Color fundus photograph — 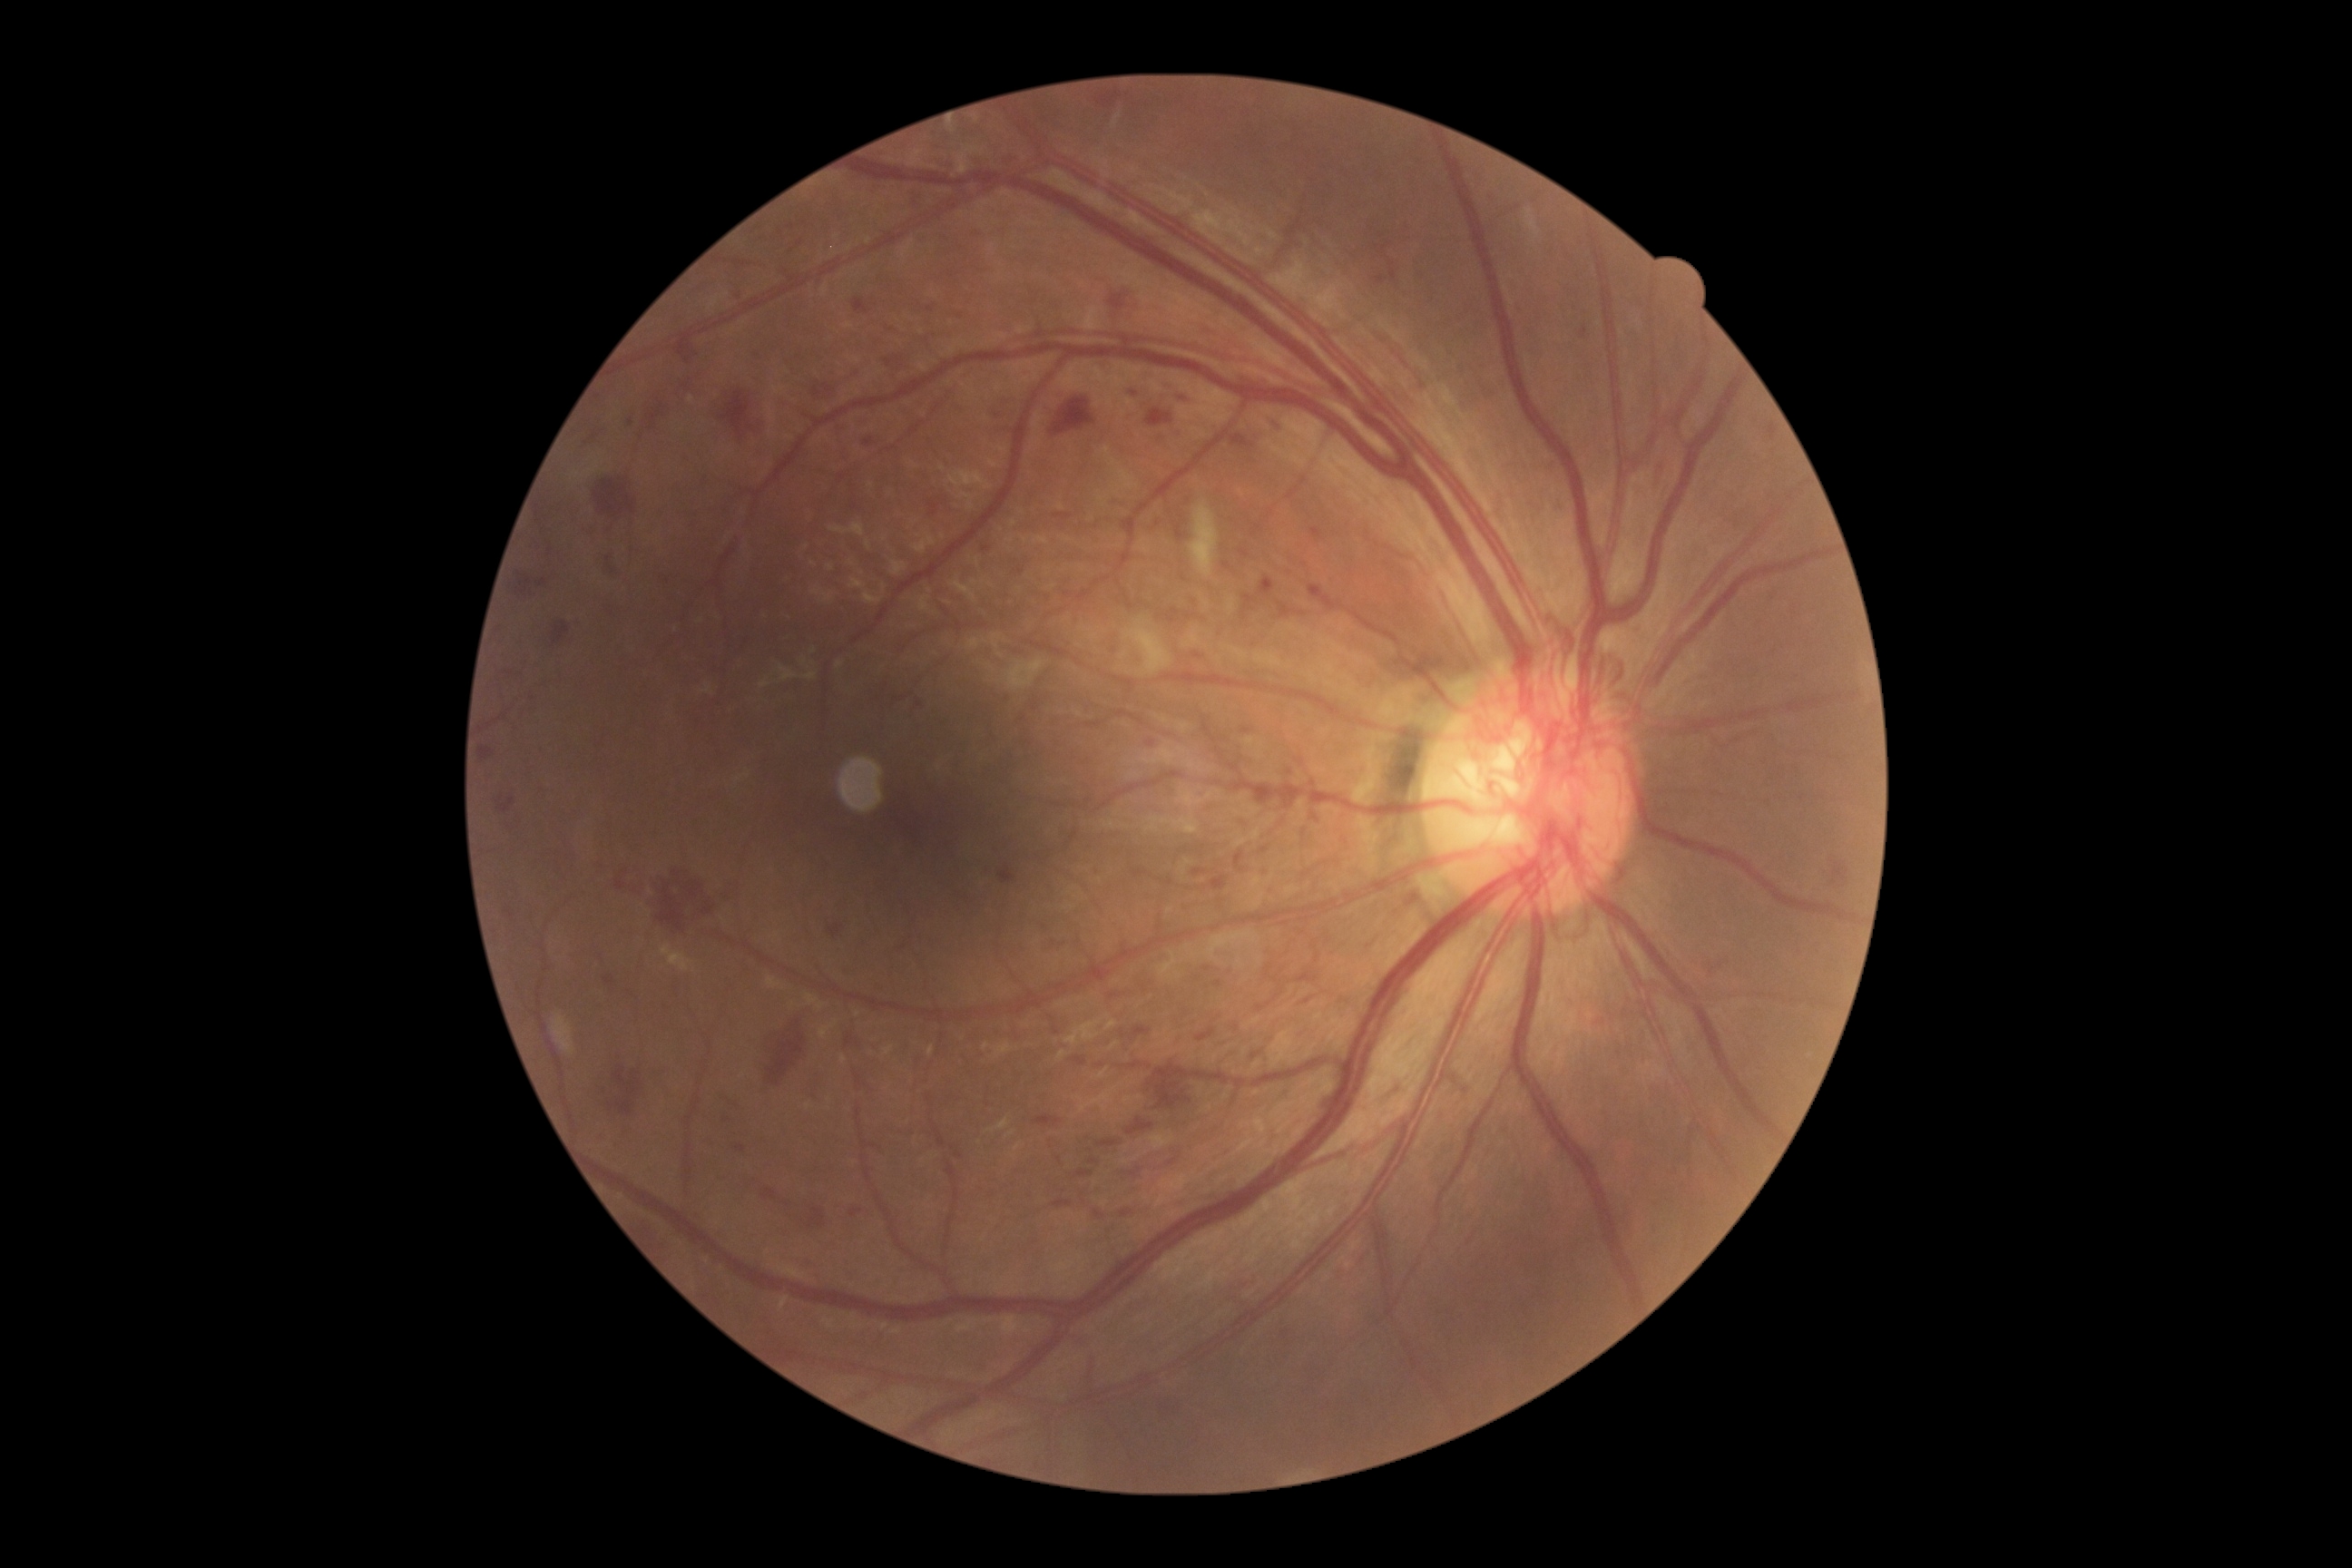

Diabetic retinopathy (DR) is grade 4 (PDR). Hemorrhages (HEs) include rect(1121, 1208, 1133, 1219) | rect(1260, 578, 1275, 598) | rect(1175, 525, 1184, 540) | rect(498, 663, 525, 676) | rect(990, 400, 1014, 416) | rect(602, 1057, 638, 1117) | rect(607, 556, 618, 574) | rect(1288, 783, 1306, 808) | rect(647, 404, 667, 431) | rect(999, 867, 1015, 885) | rect(1052, 400, 1095, 436) | rect(761, 1190, 778, 1200) | rect(1130, 1063, 1141, 1070) | rect(1211, 876, 1228, 890) | rect(1126, 386, 1141, 397) | rect(1391, 262, 1398, 282) | rect(823, 386, 834, 395) | rect(618, 865, 640, 897) | rect(1304, 999, 1313, 1004). HEs (small, approximate centers) near pt(1101, 1066).